Modified Davis grading:
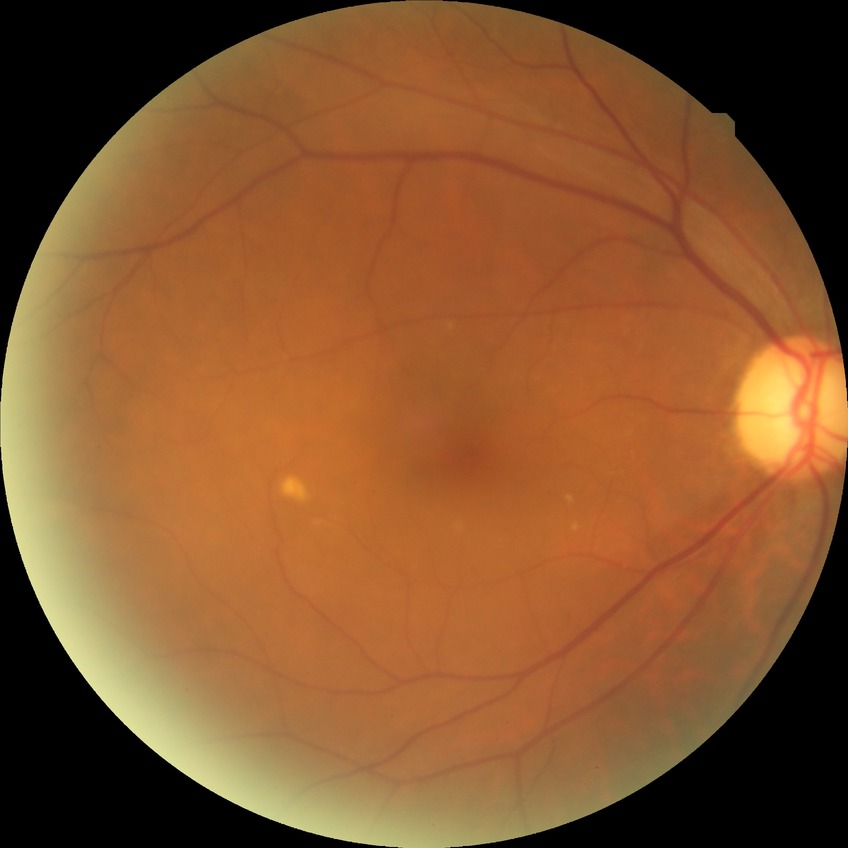
  davis_grade: no diabetic retinopathy